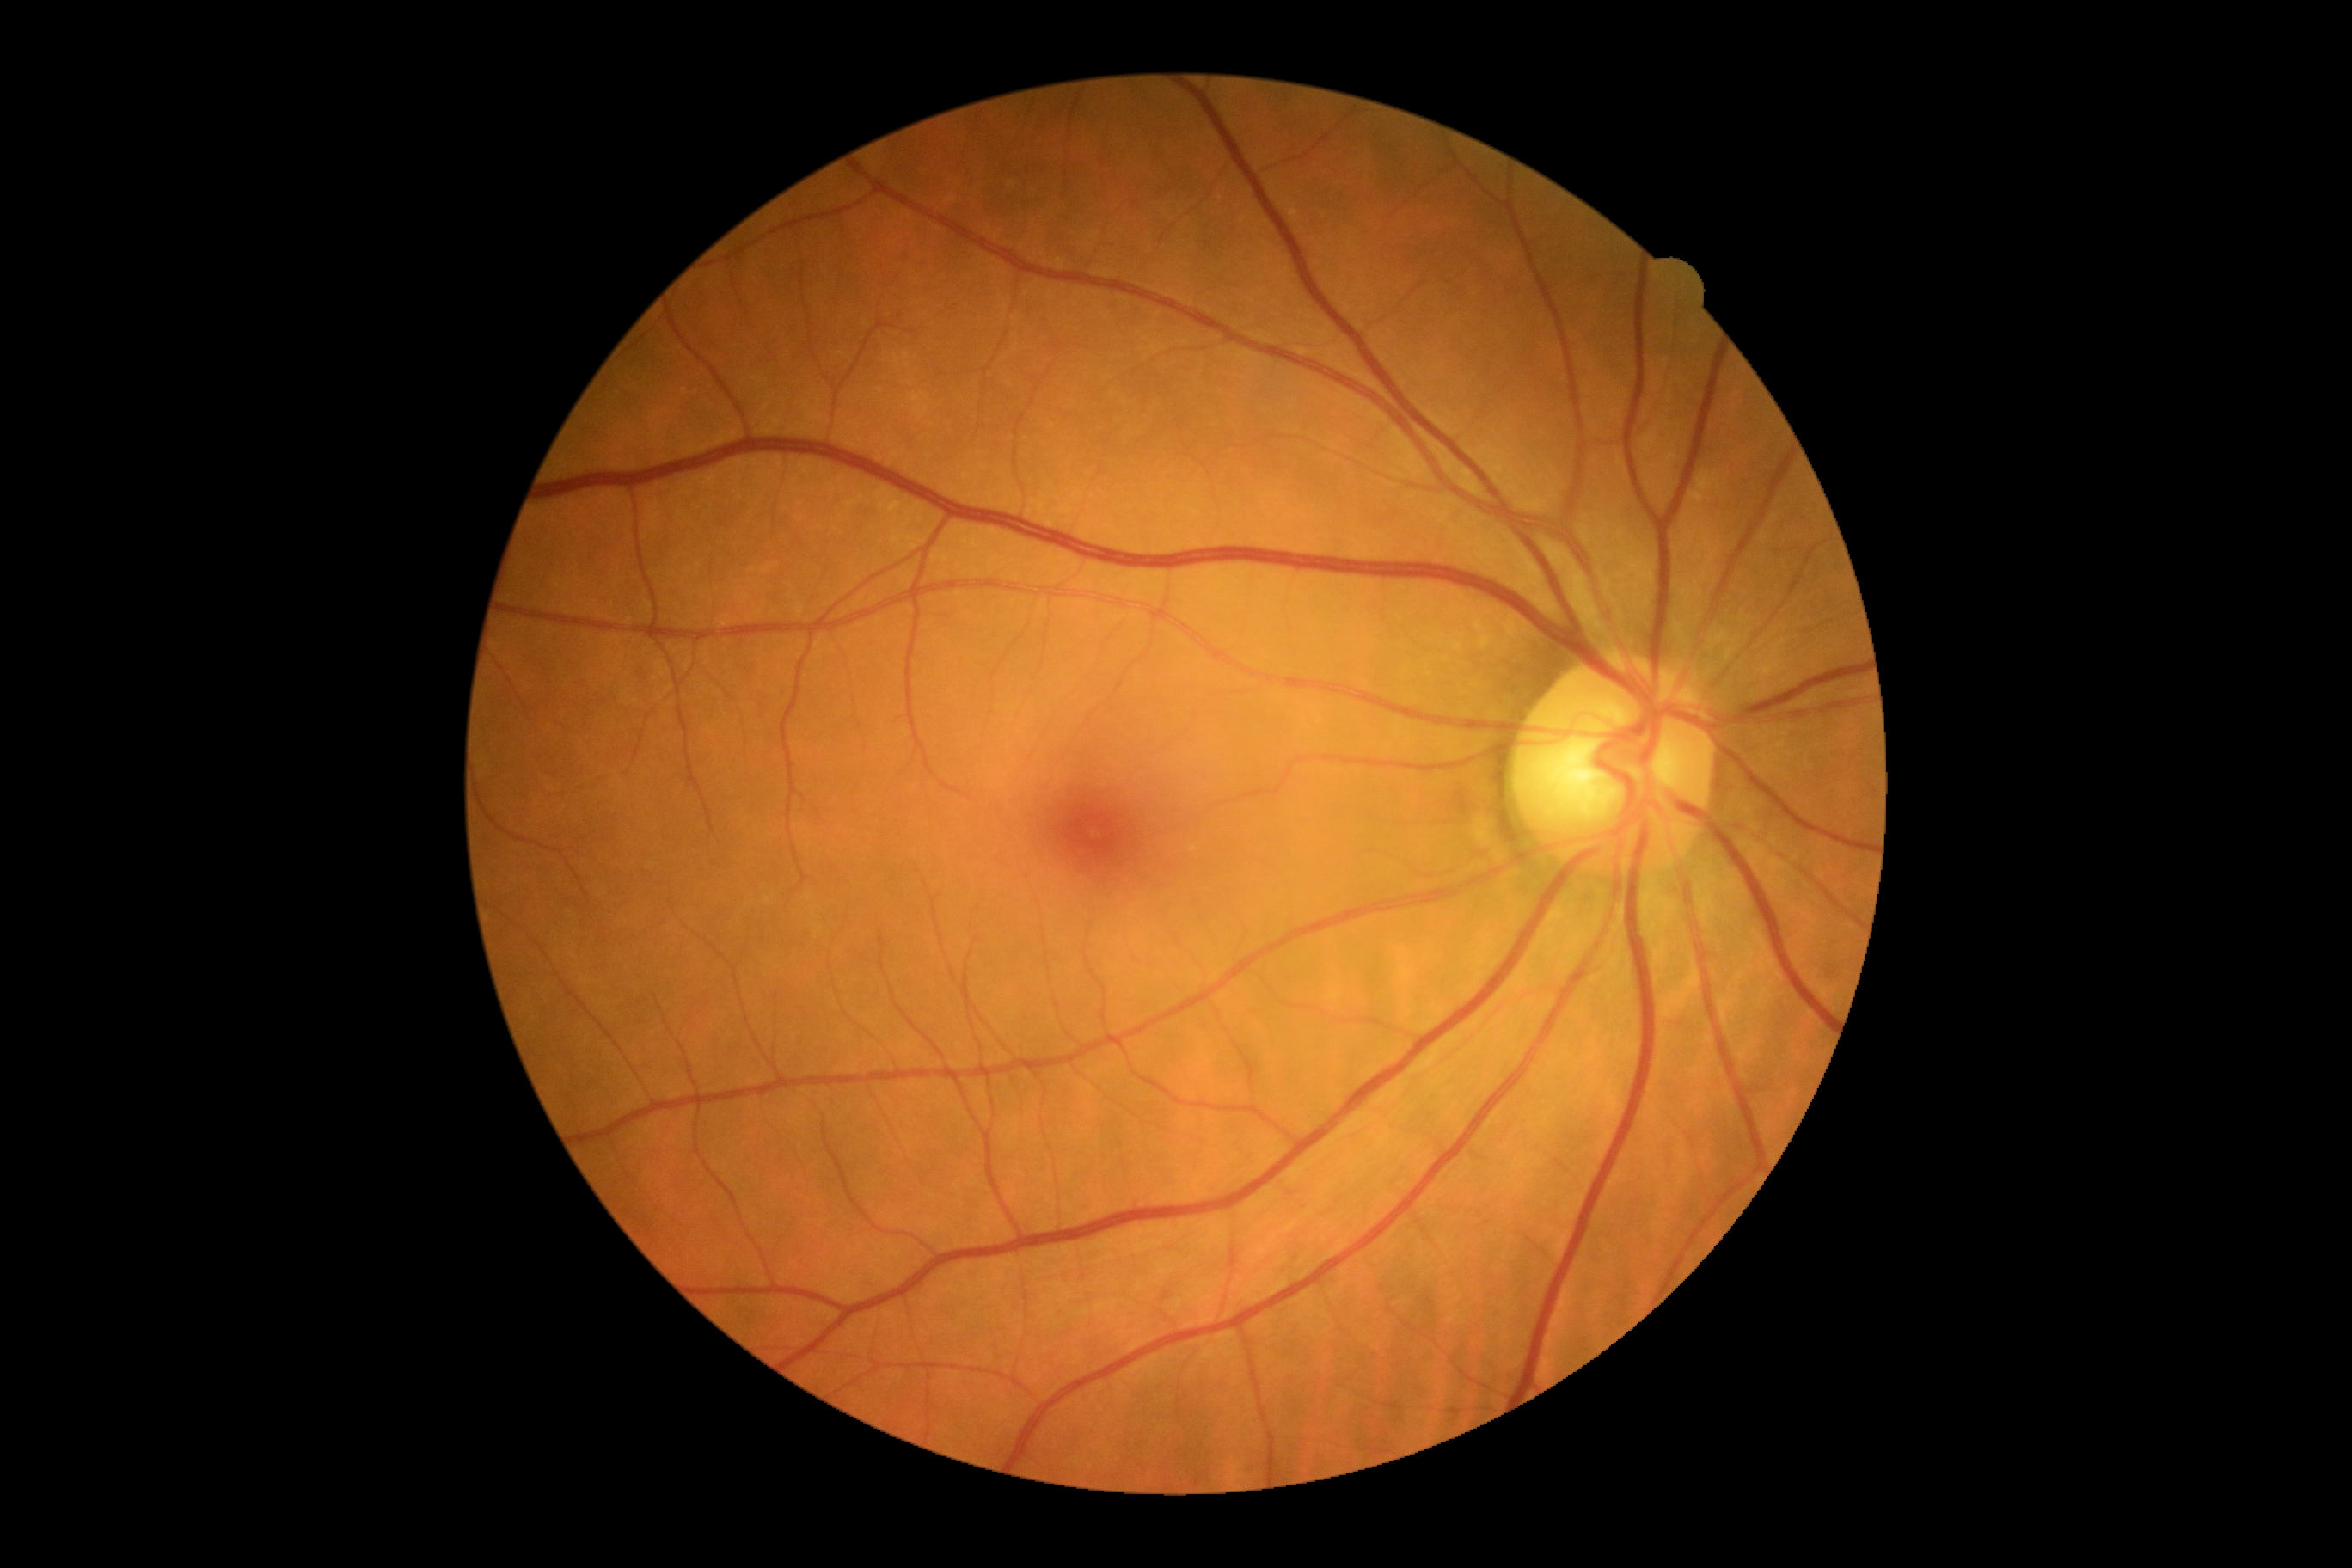
Diabetic retinopathy: 0/4.
No apparent diabetic retinopathy.